FOV: 50 degrees; 2228x1652; posterior pole view; captured after pupil dilation.
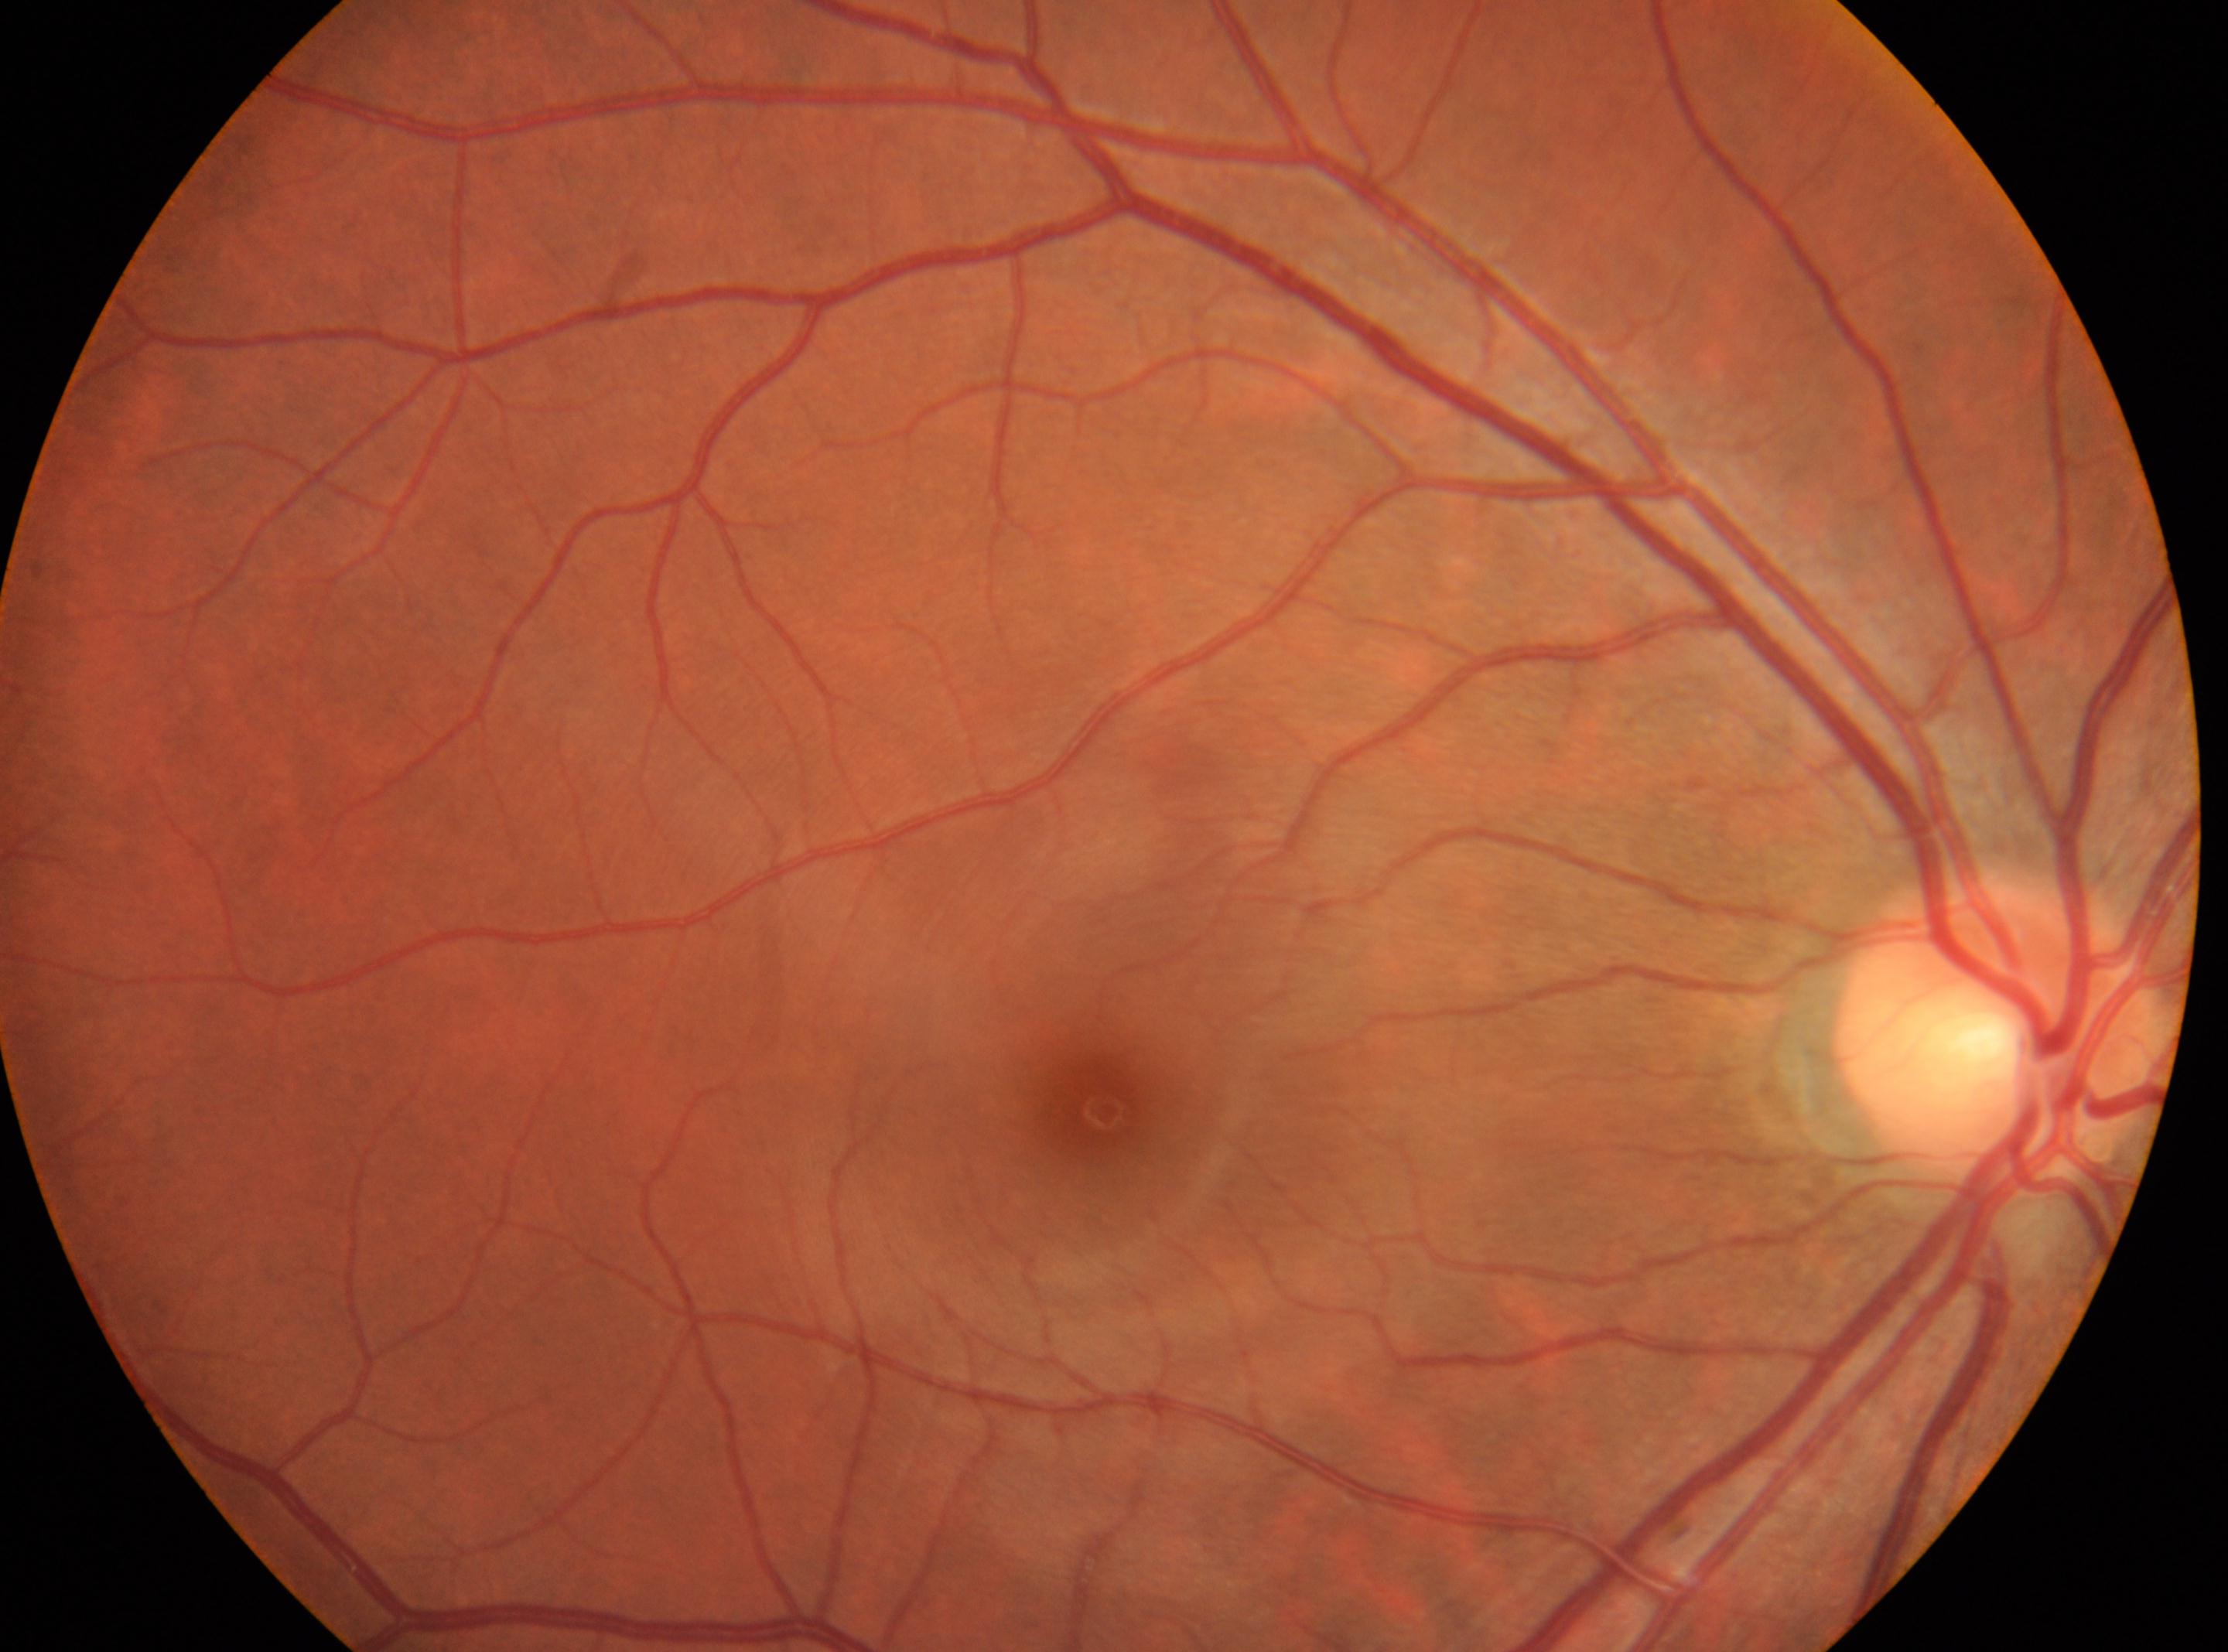 DR severity = no apparent retinopathy (grade 0) — no visible signs of diabetic retinopathy, foveal center = [1106, 1112], optic disc = [1999, 1036], DR impression = No diabetic retinal disease findings, laterality = oculus dexter.